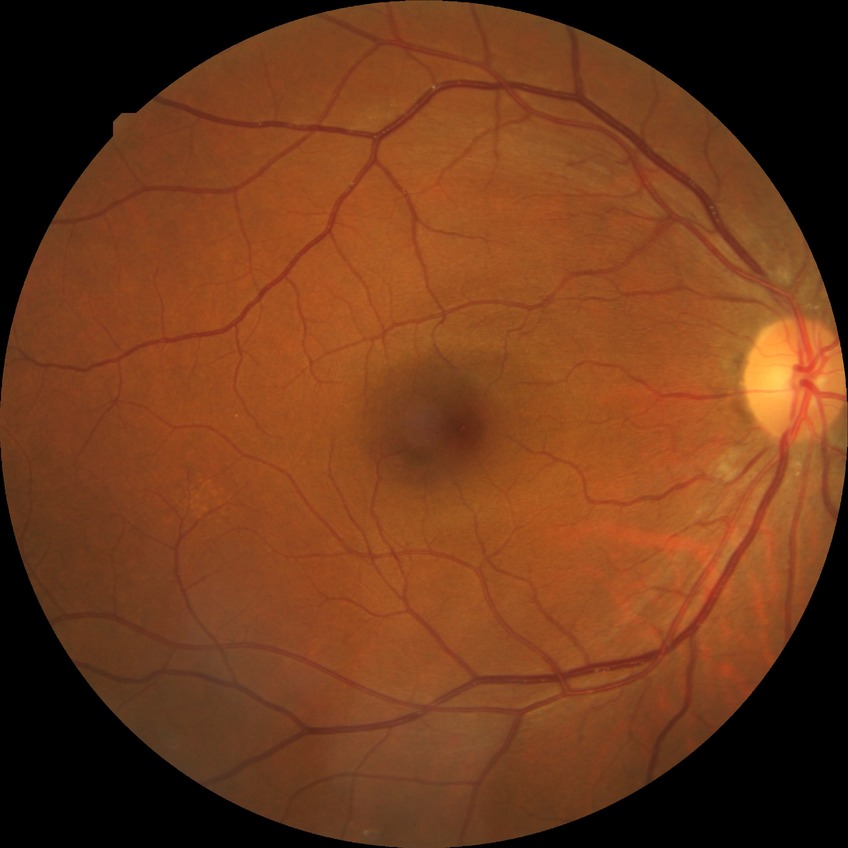 Diabetic retinopathy severity: no diabetic retinopathy.